Portable fundus photograph — 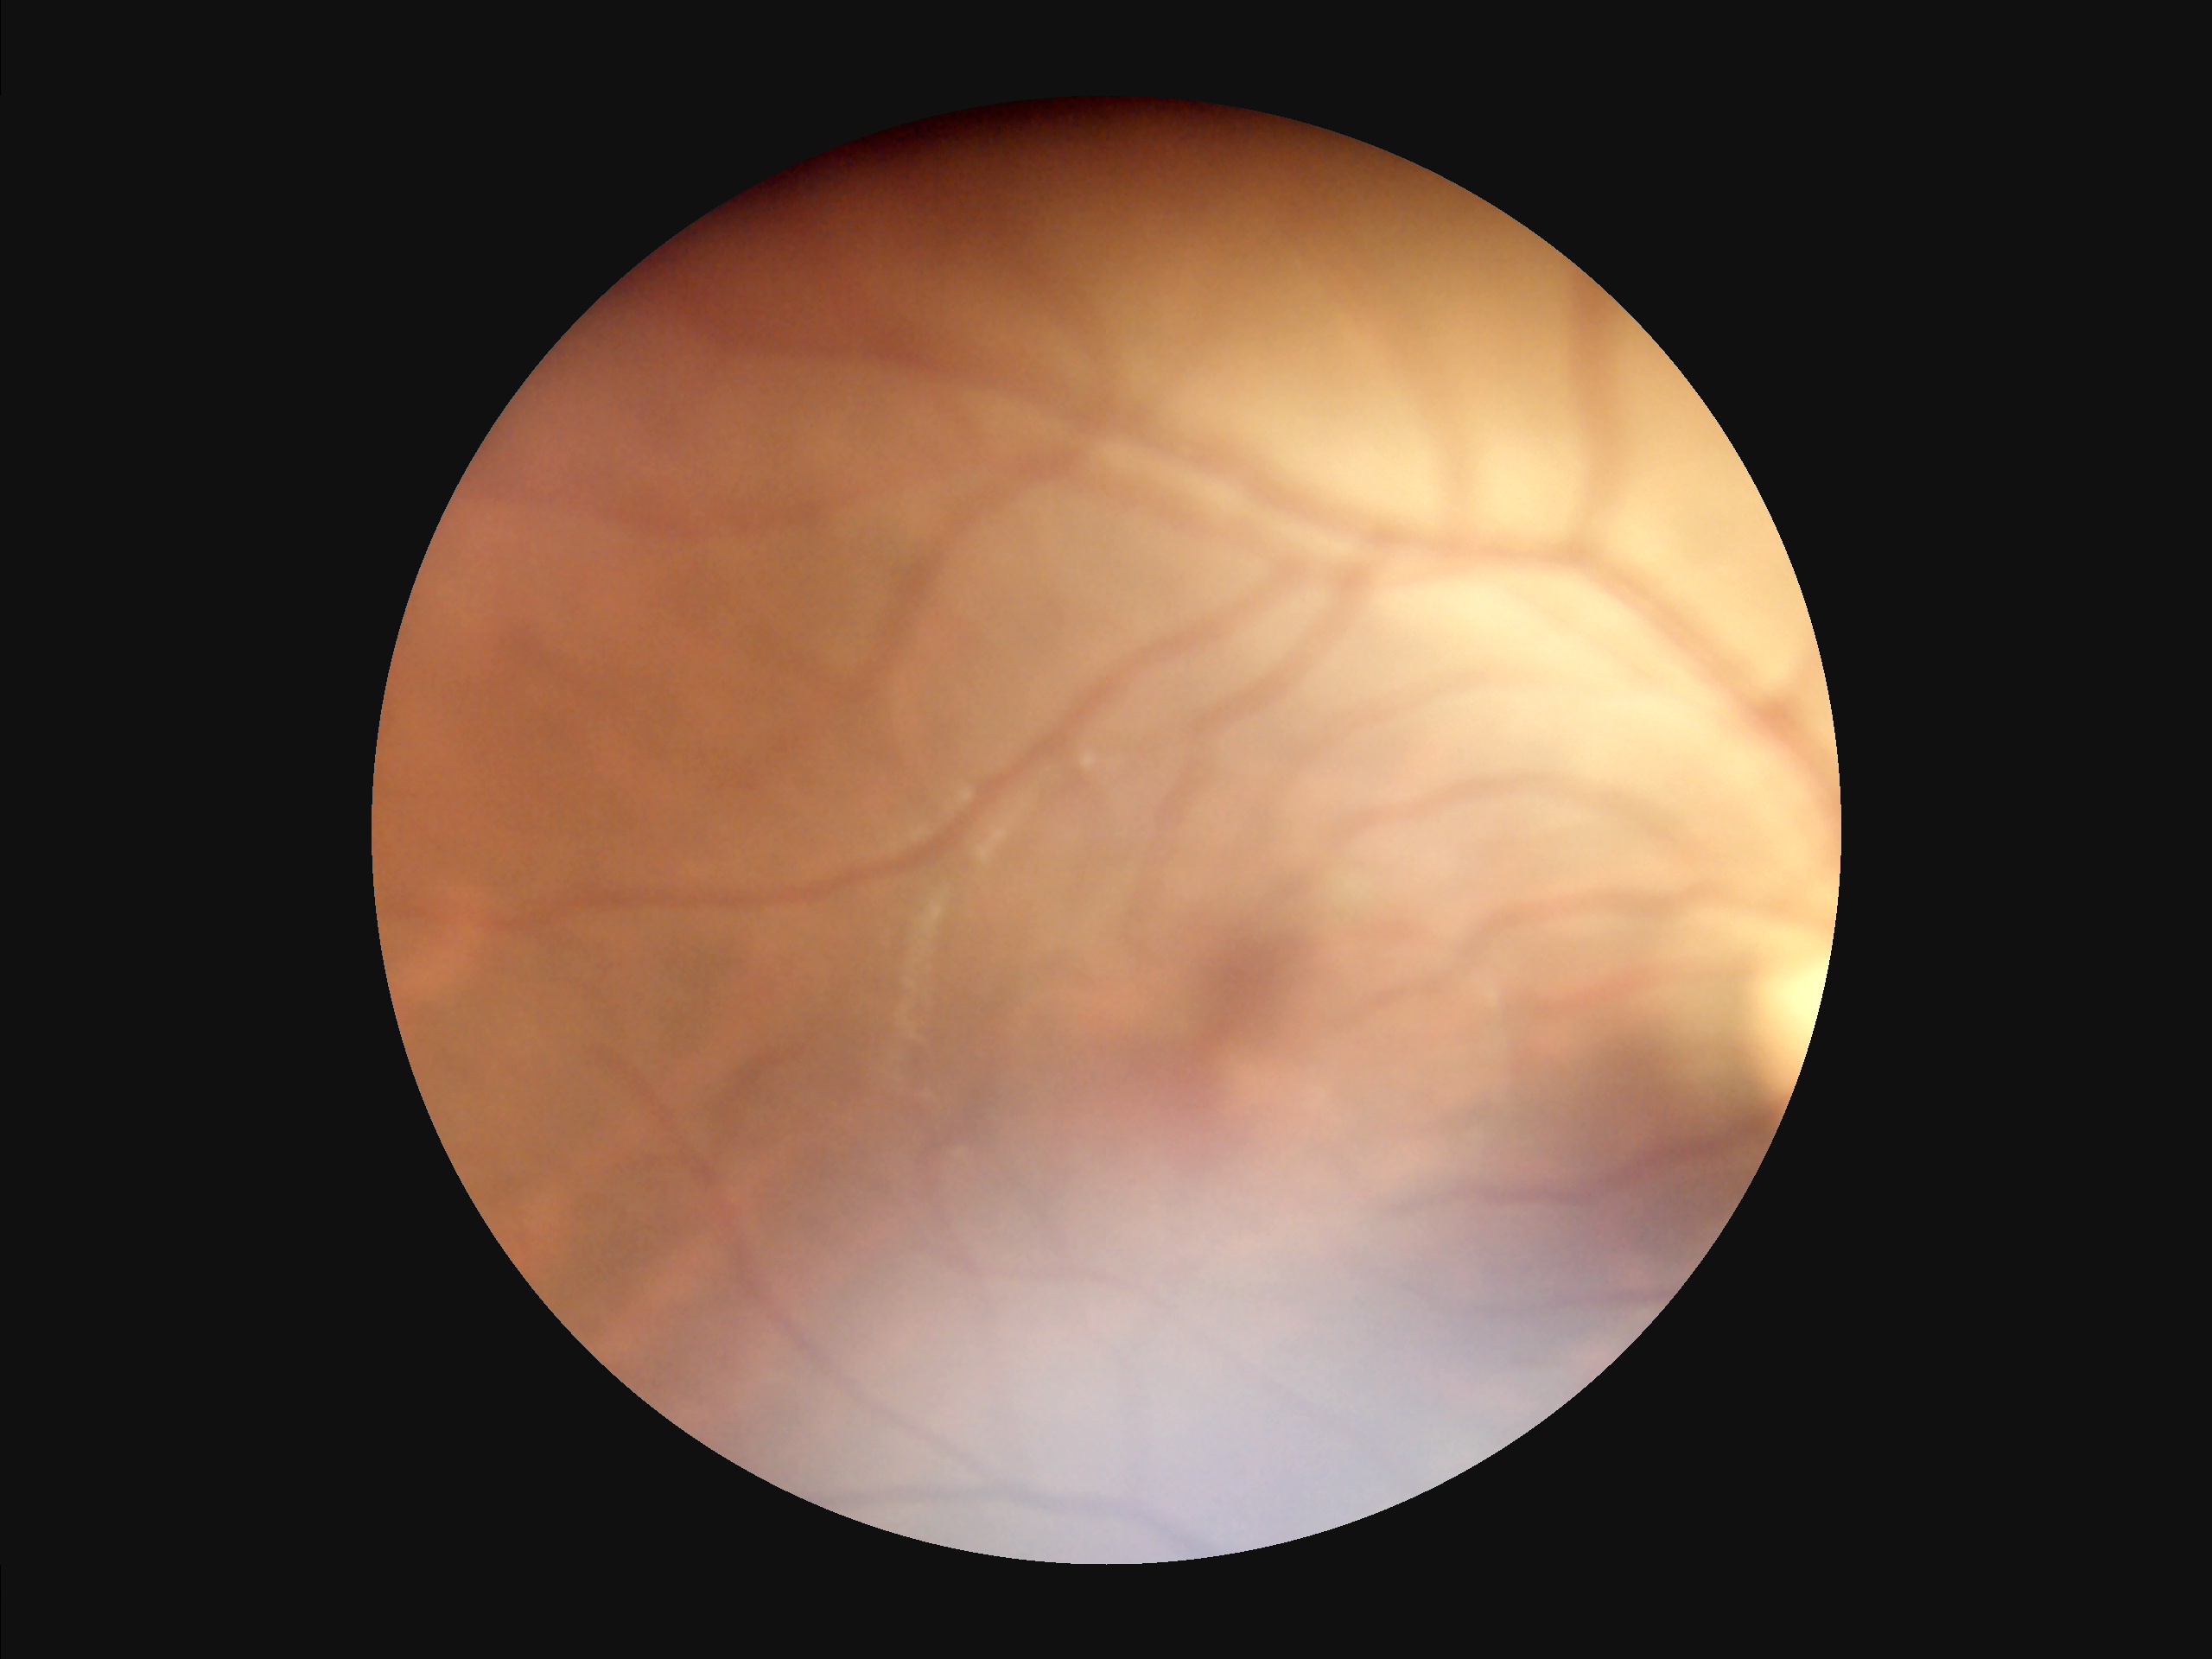   clarity: noticeable blur in the optic disc, vessels, or background
  illumination: uneven illumination or color cast
  overall_quality: poor, ungradable
  contrast: low, vessels and details hard to distinguish